RetCam wide-field infant fundus image. 130° field of view (Clarity RetCam 3). 640x480px: 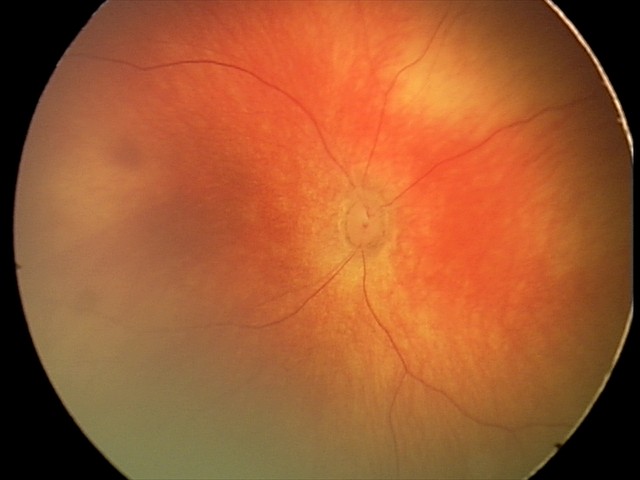
Series diagnosed as retinal hemorrhages.